45-degree field of view
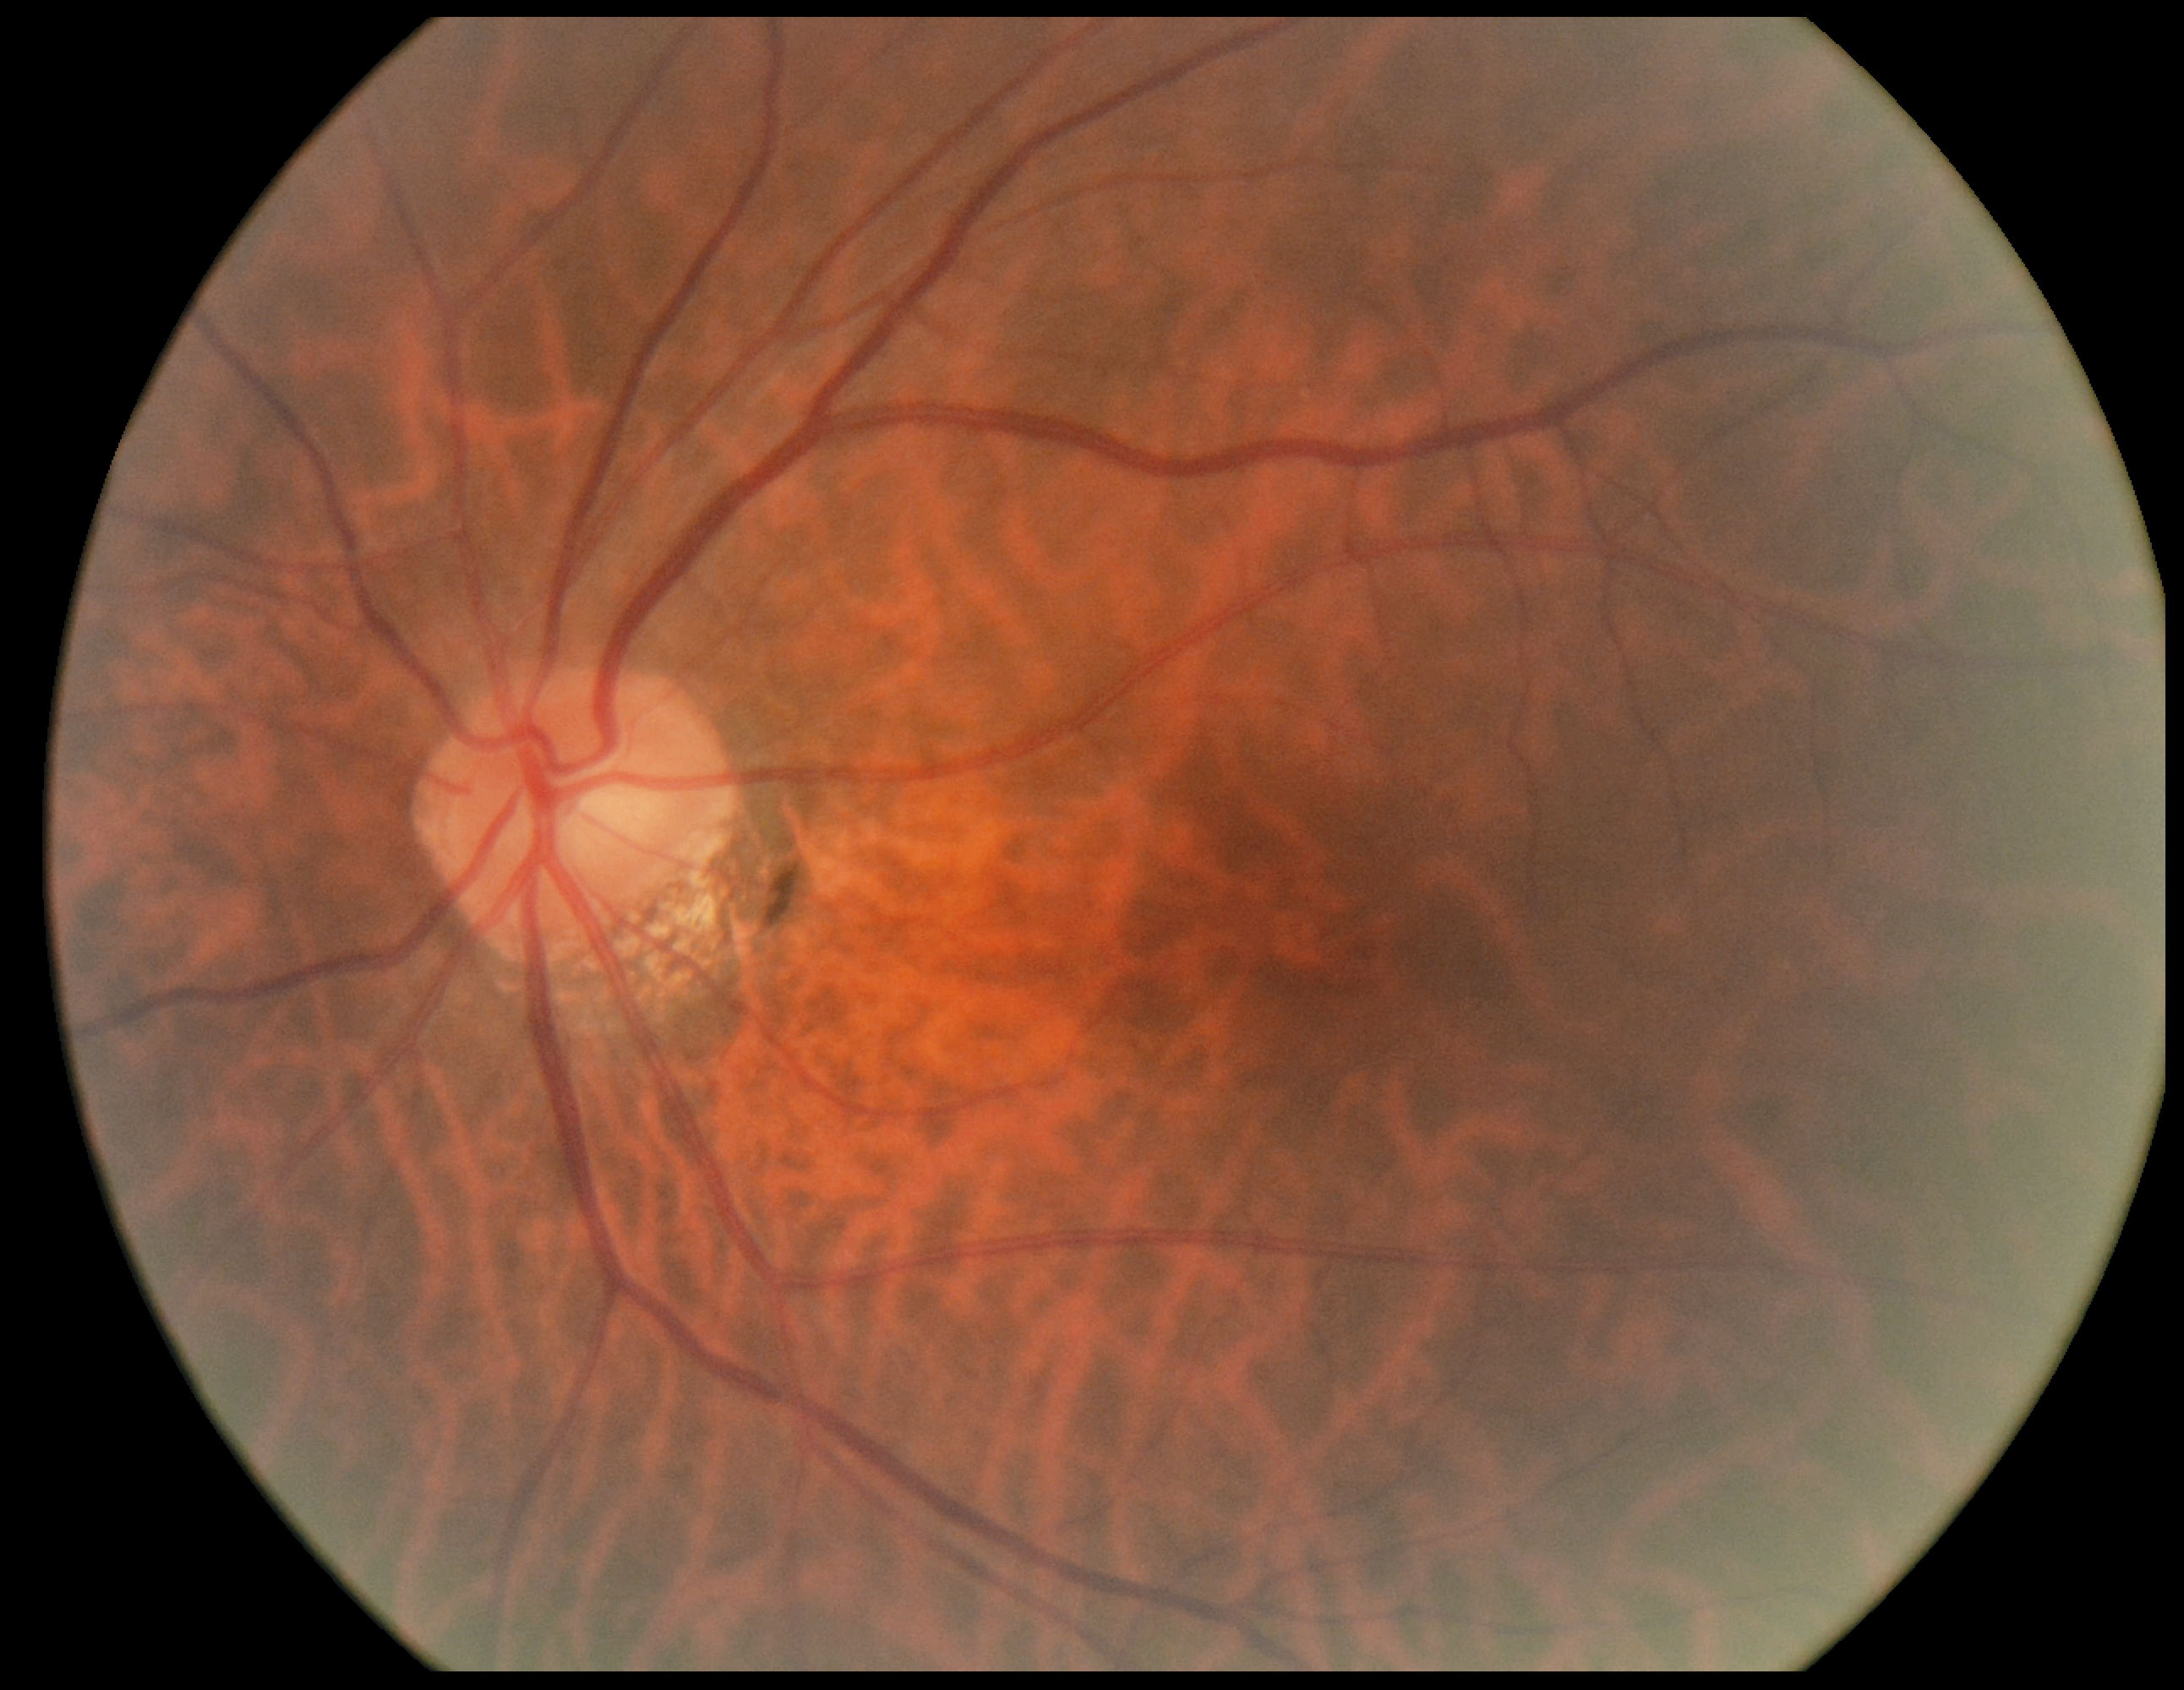 No DR findings. Retinopathy is no apparent retinopathy (grade 0) — no visible signs of diabetic retinopathy.